Modified Davis classification:
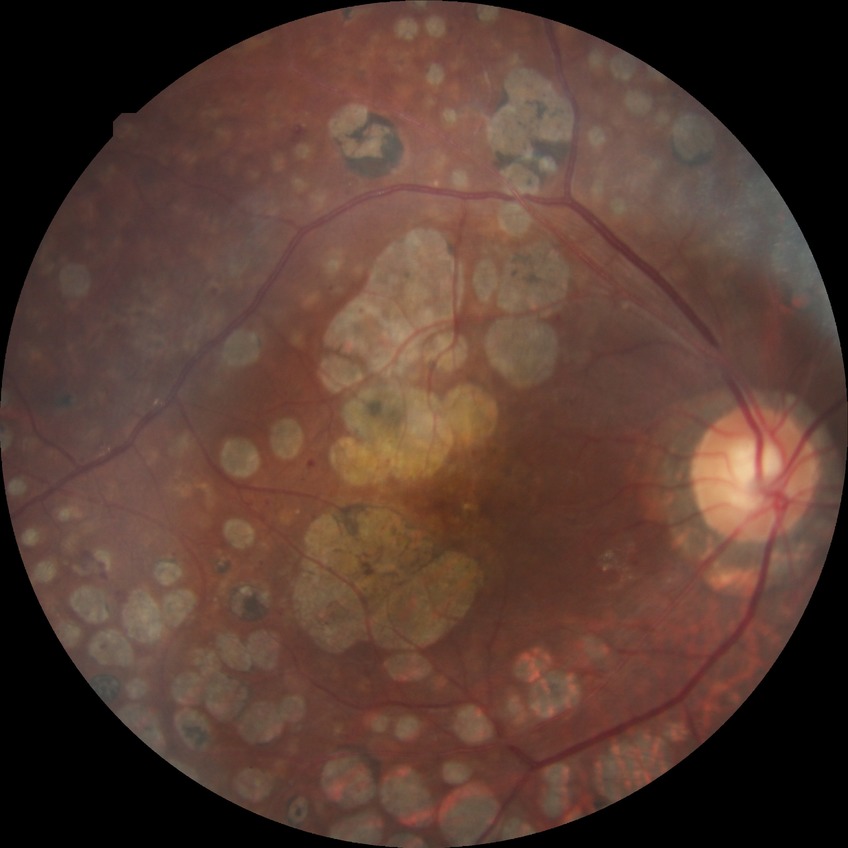
davis_grade: proliferative diabetic retinopathy (PDR)